Posterior pole color fundus photograph: 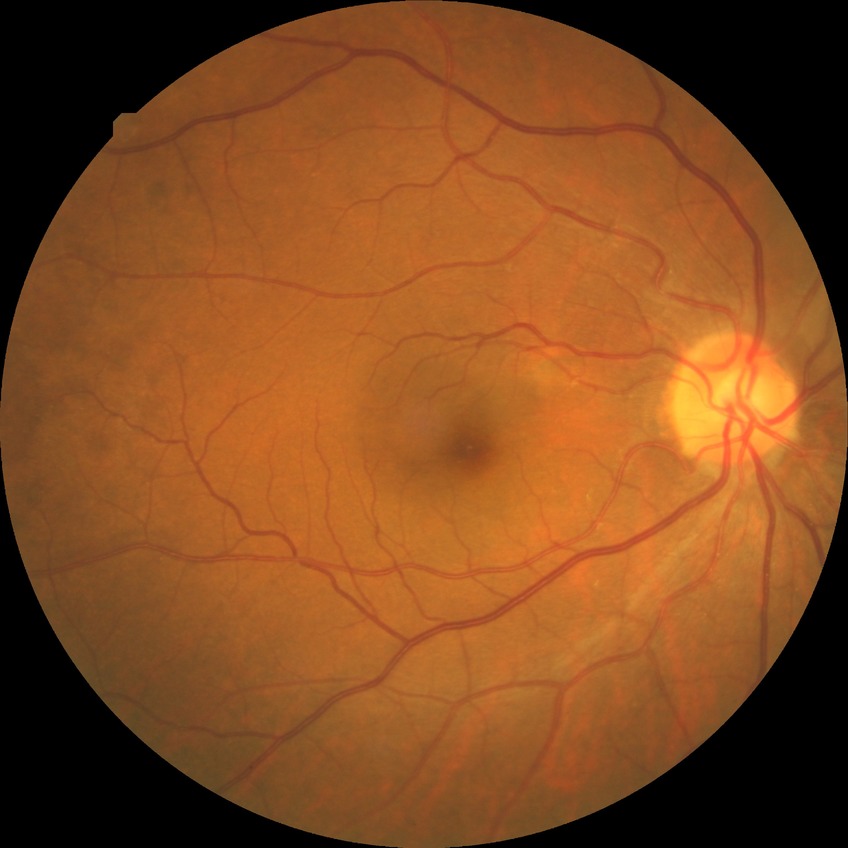 Diabetic retinopathy (DR): NDR (no diabetic retinopathy).